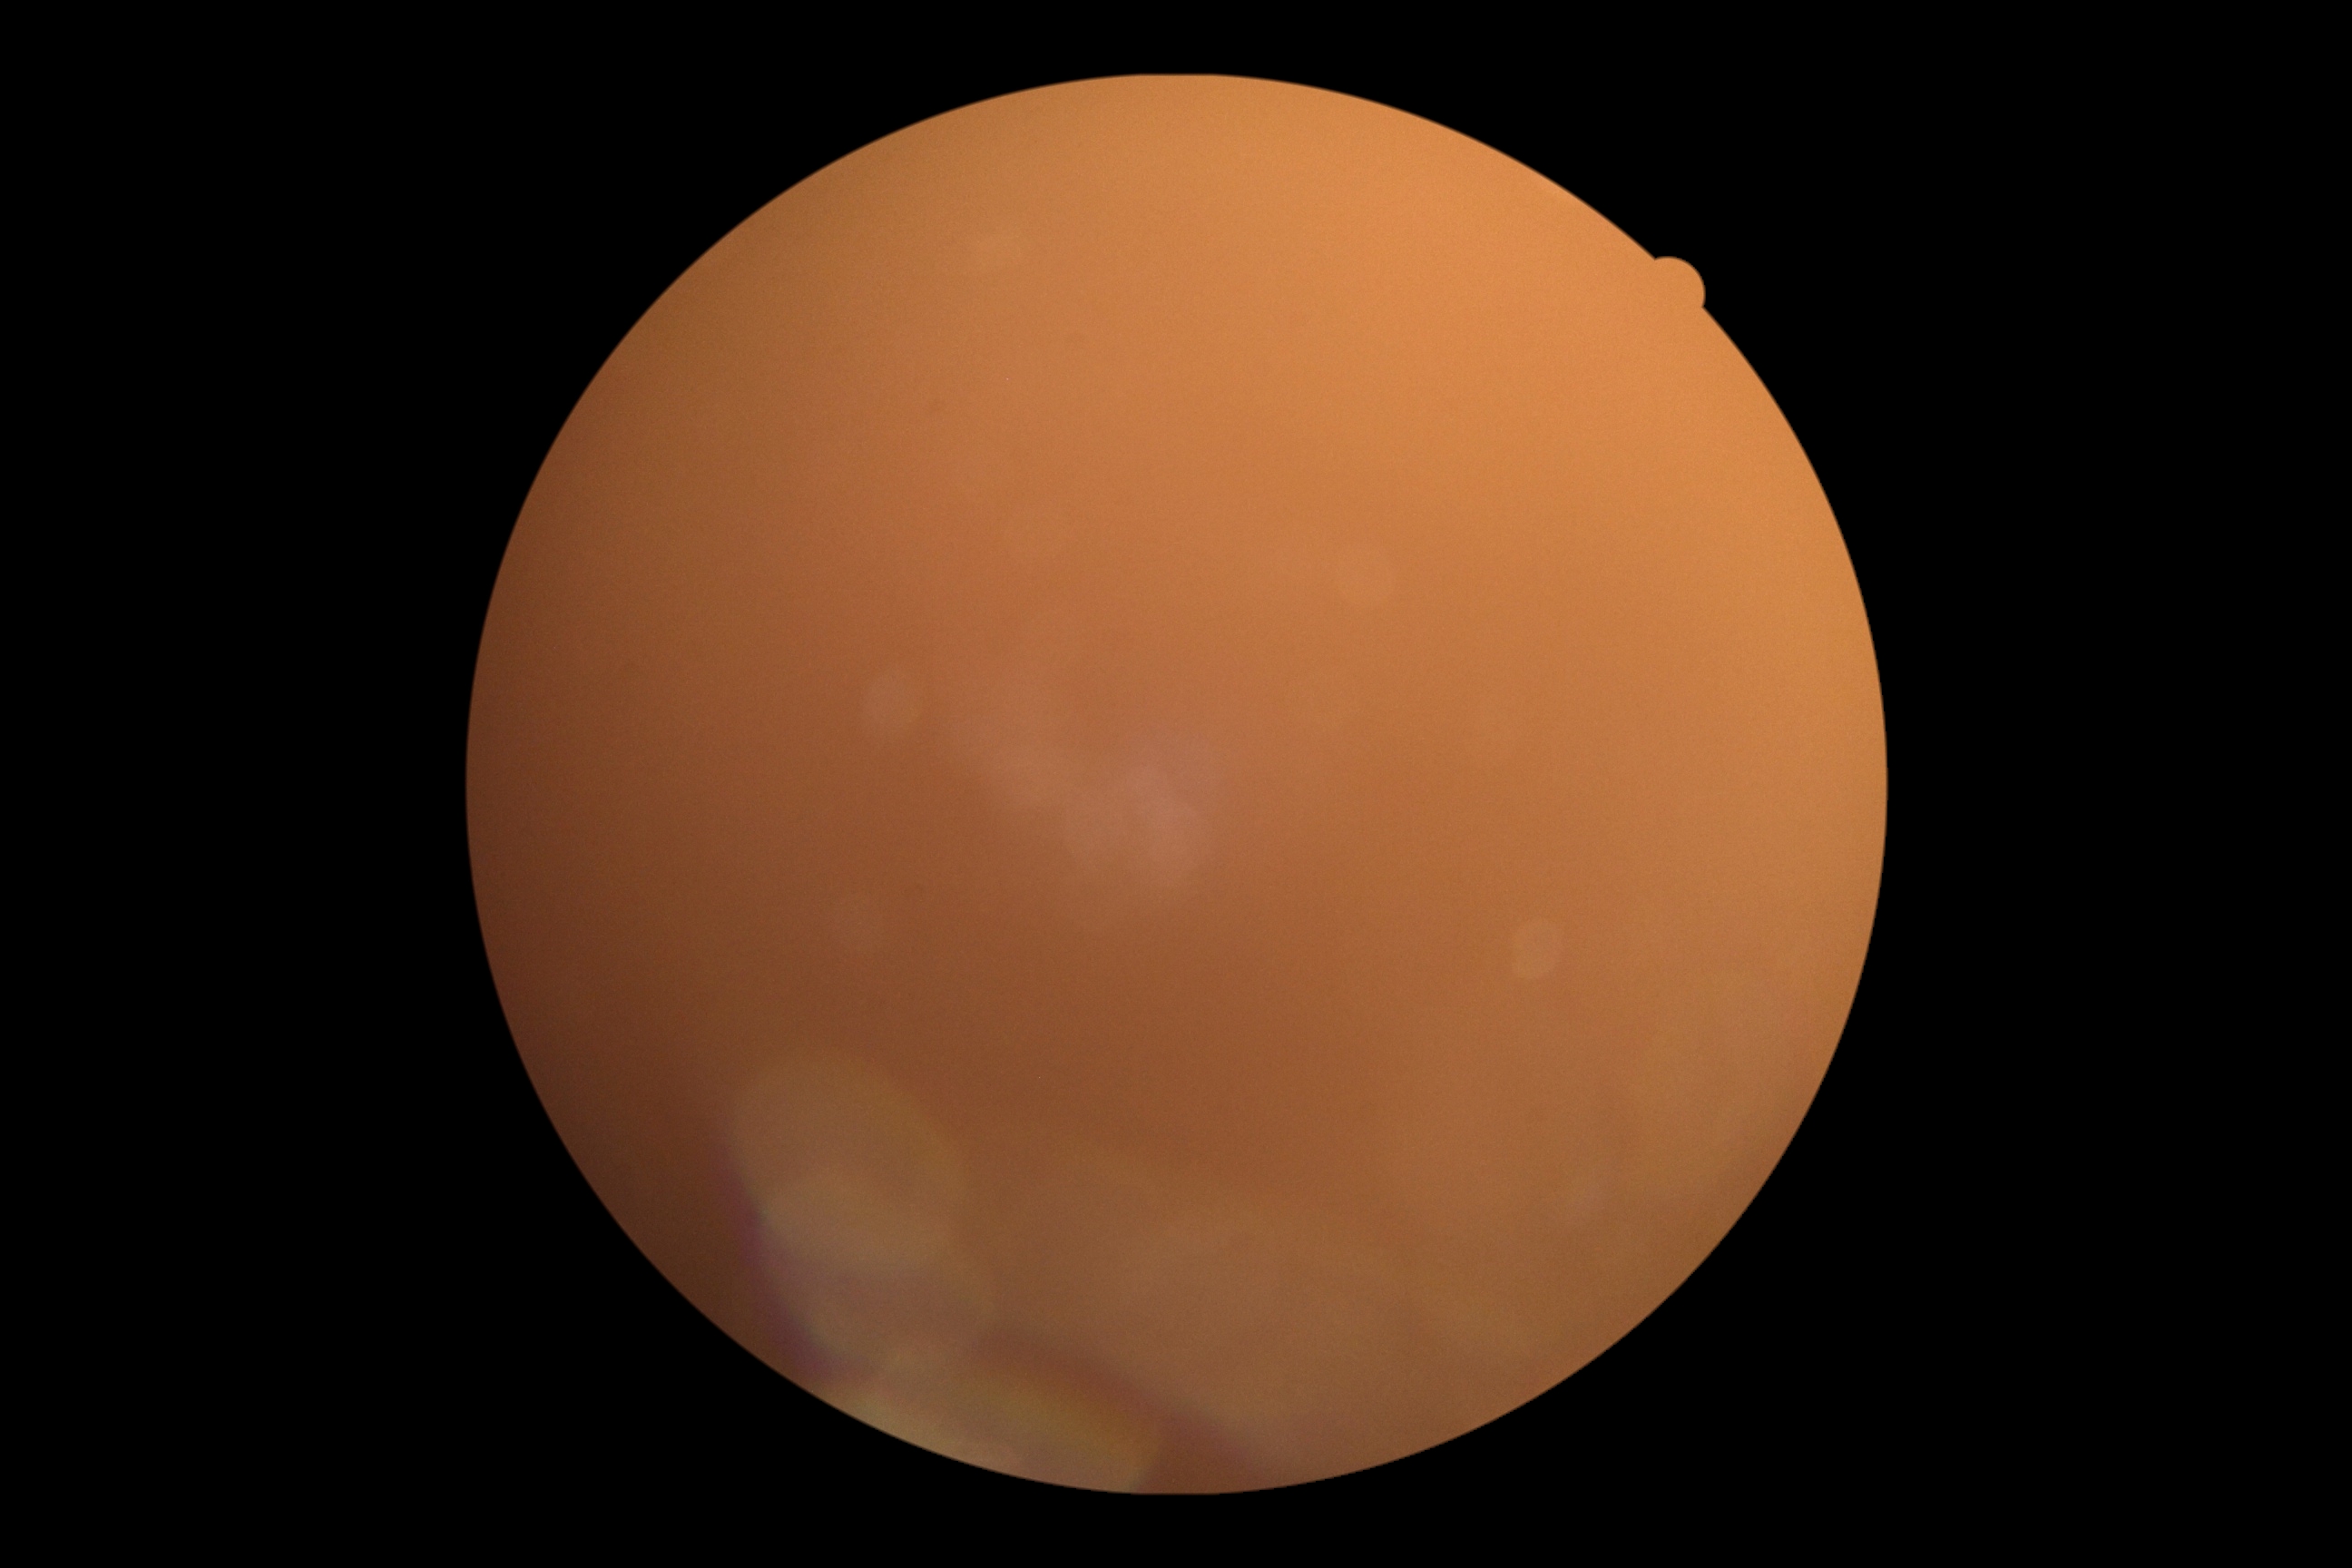

{"dr_grade": "ungradable due to poor image quality", "quality": "insufficient"}